Wide-field fundus photograph of an infant:
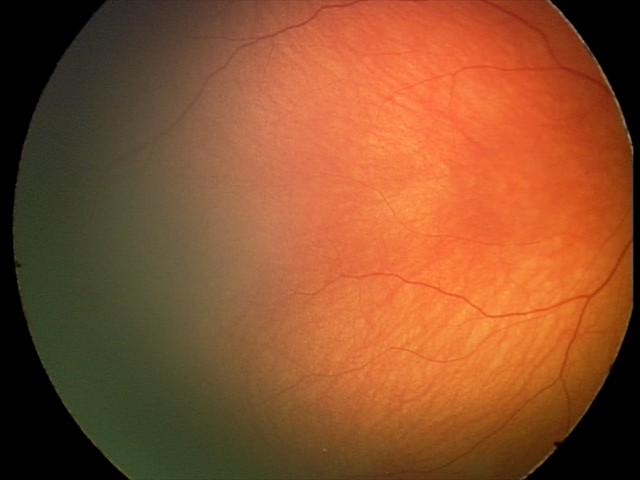

From an examination with diagnosis of optic nerve hypoplasia.